1960 by 1897 pixels, retinal fundus photograph
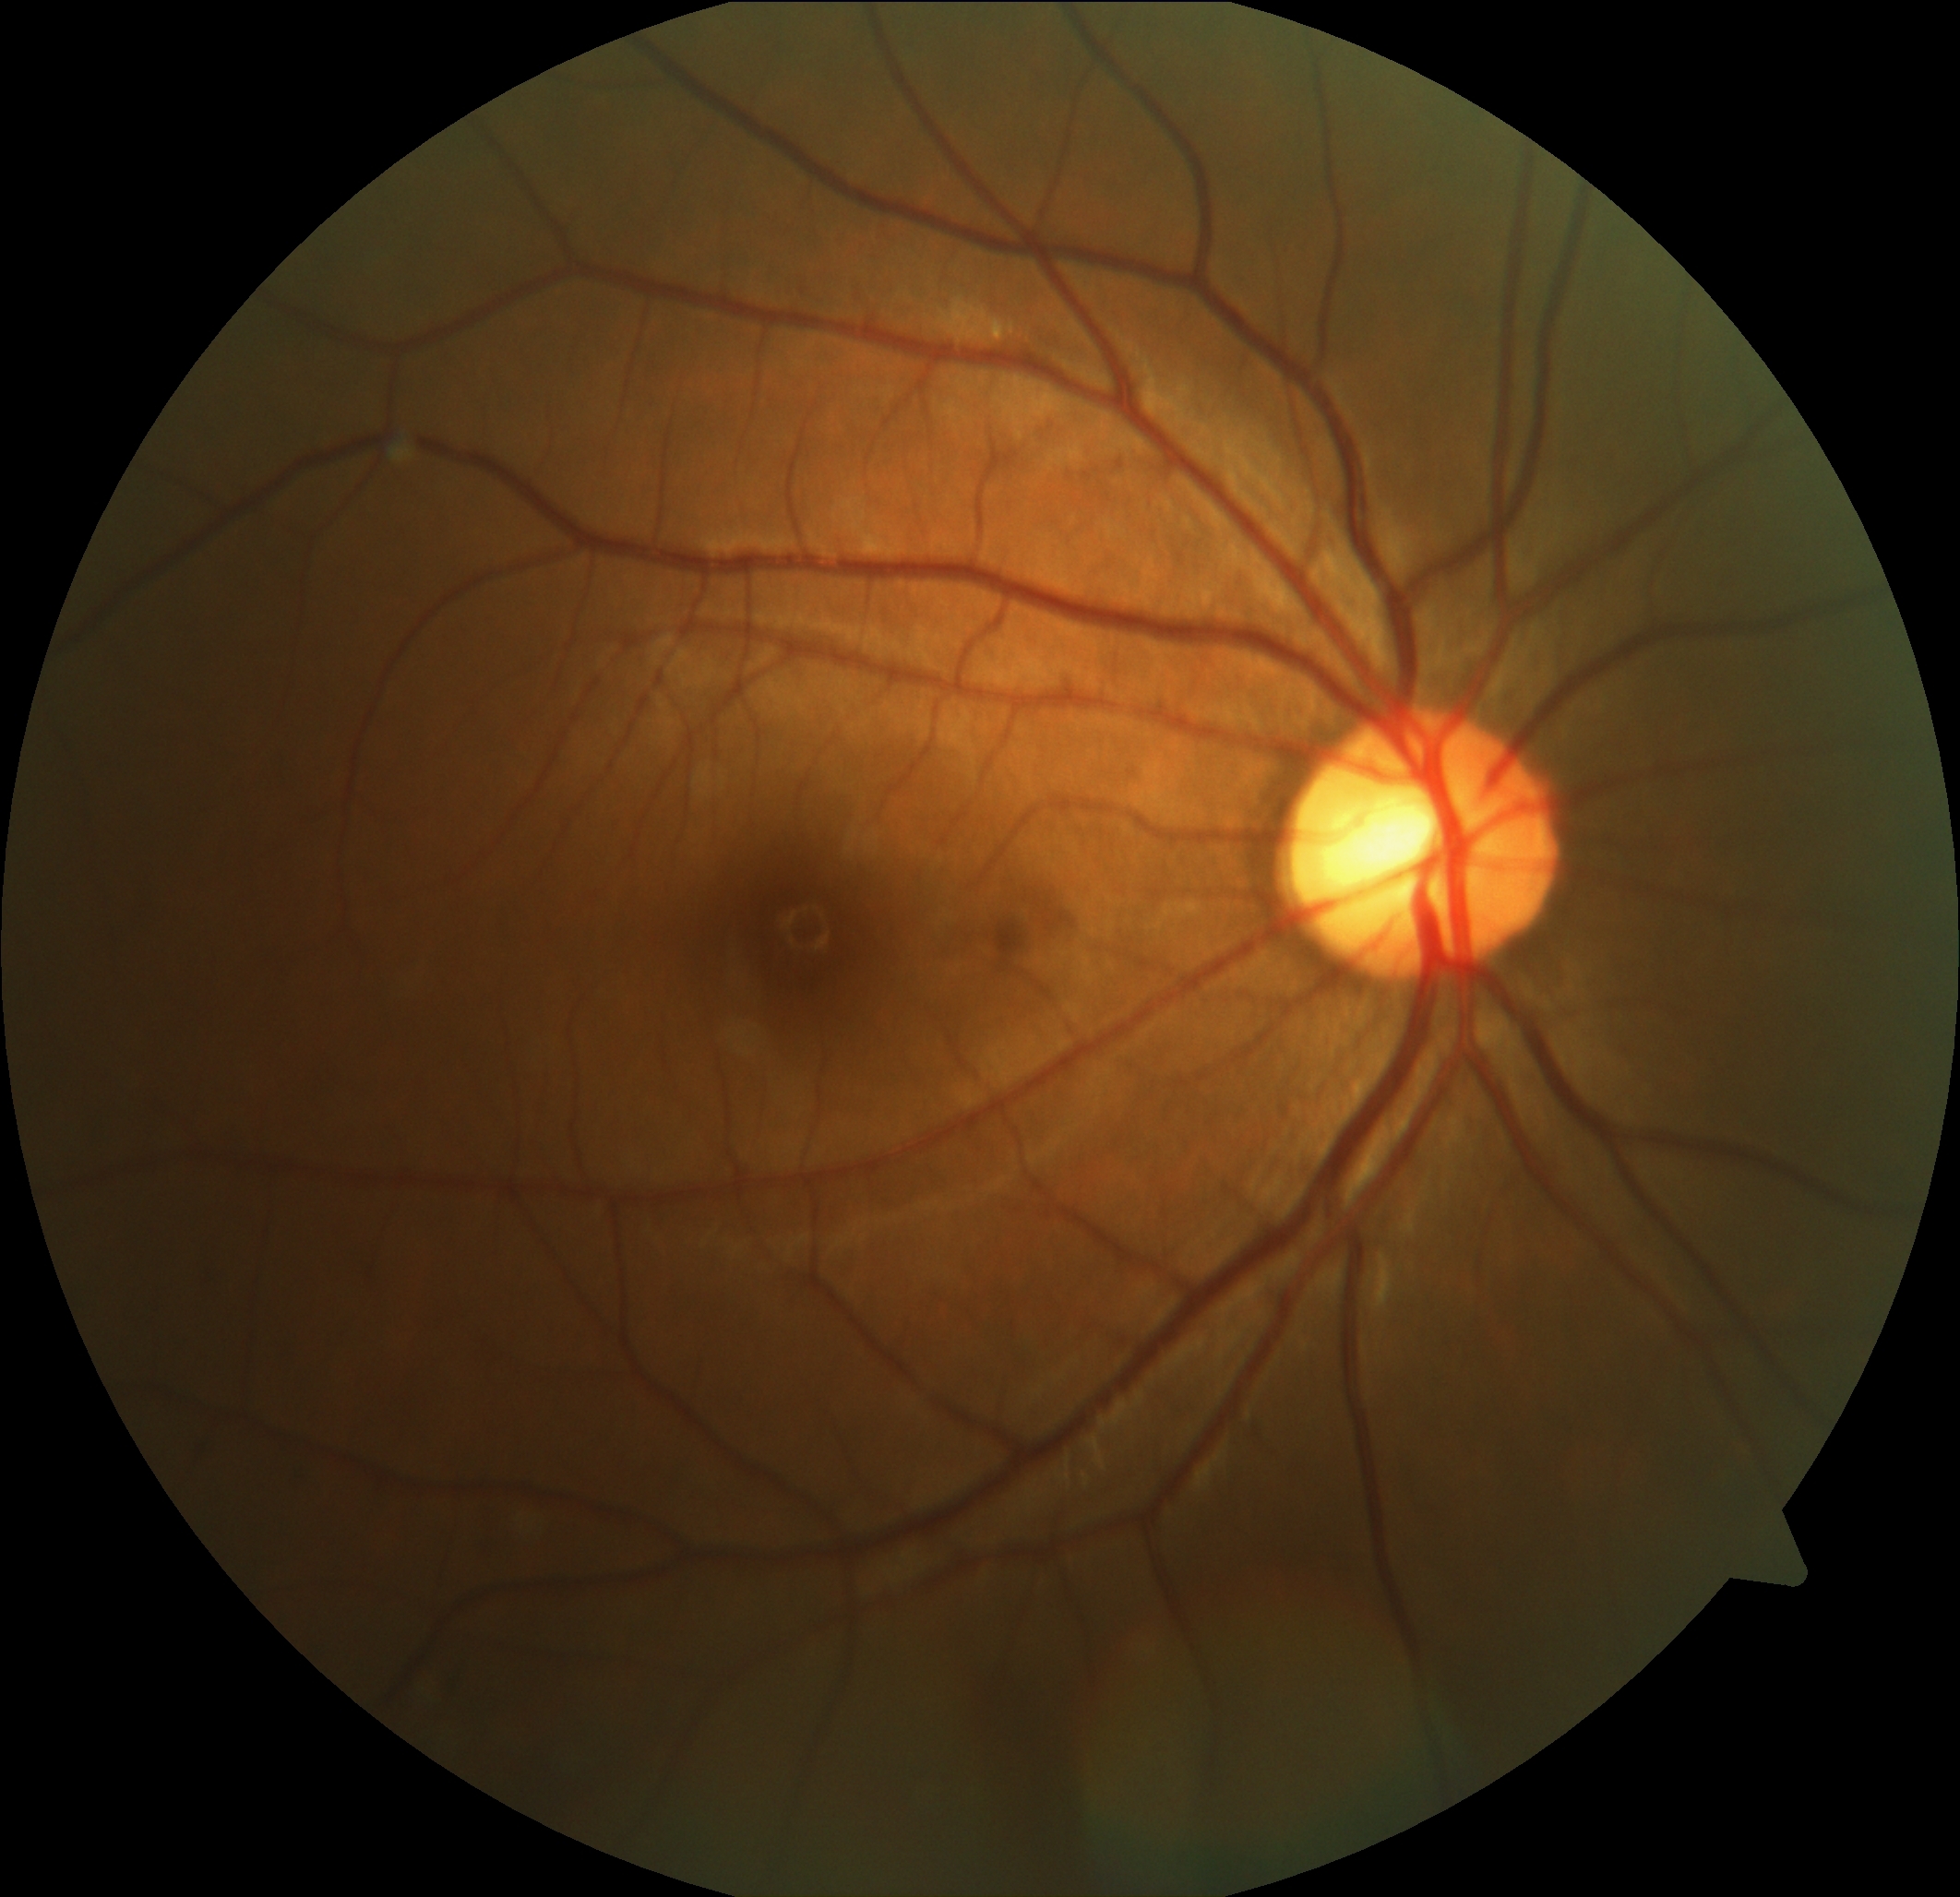 Findings:
- DR impression — no DR findings
- DR — 0